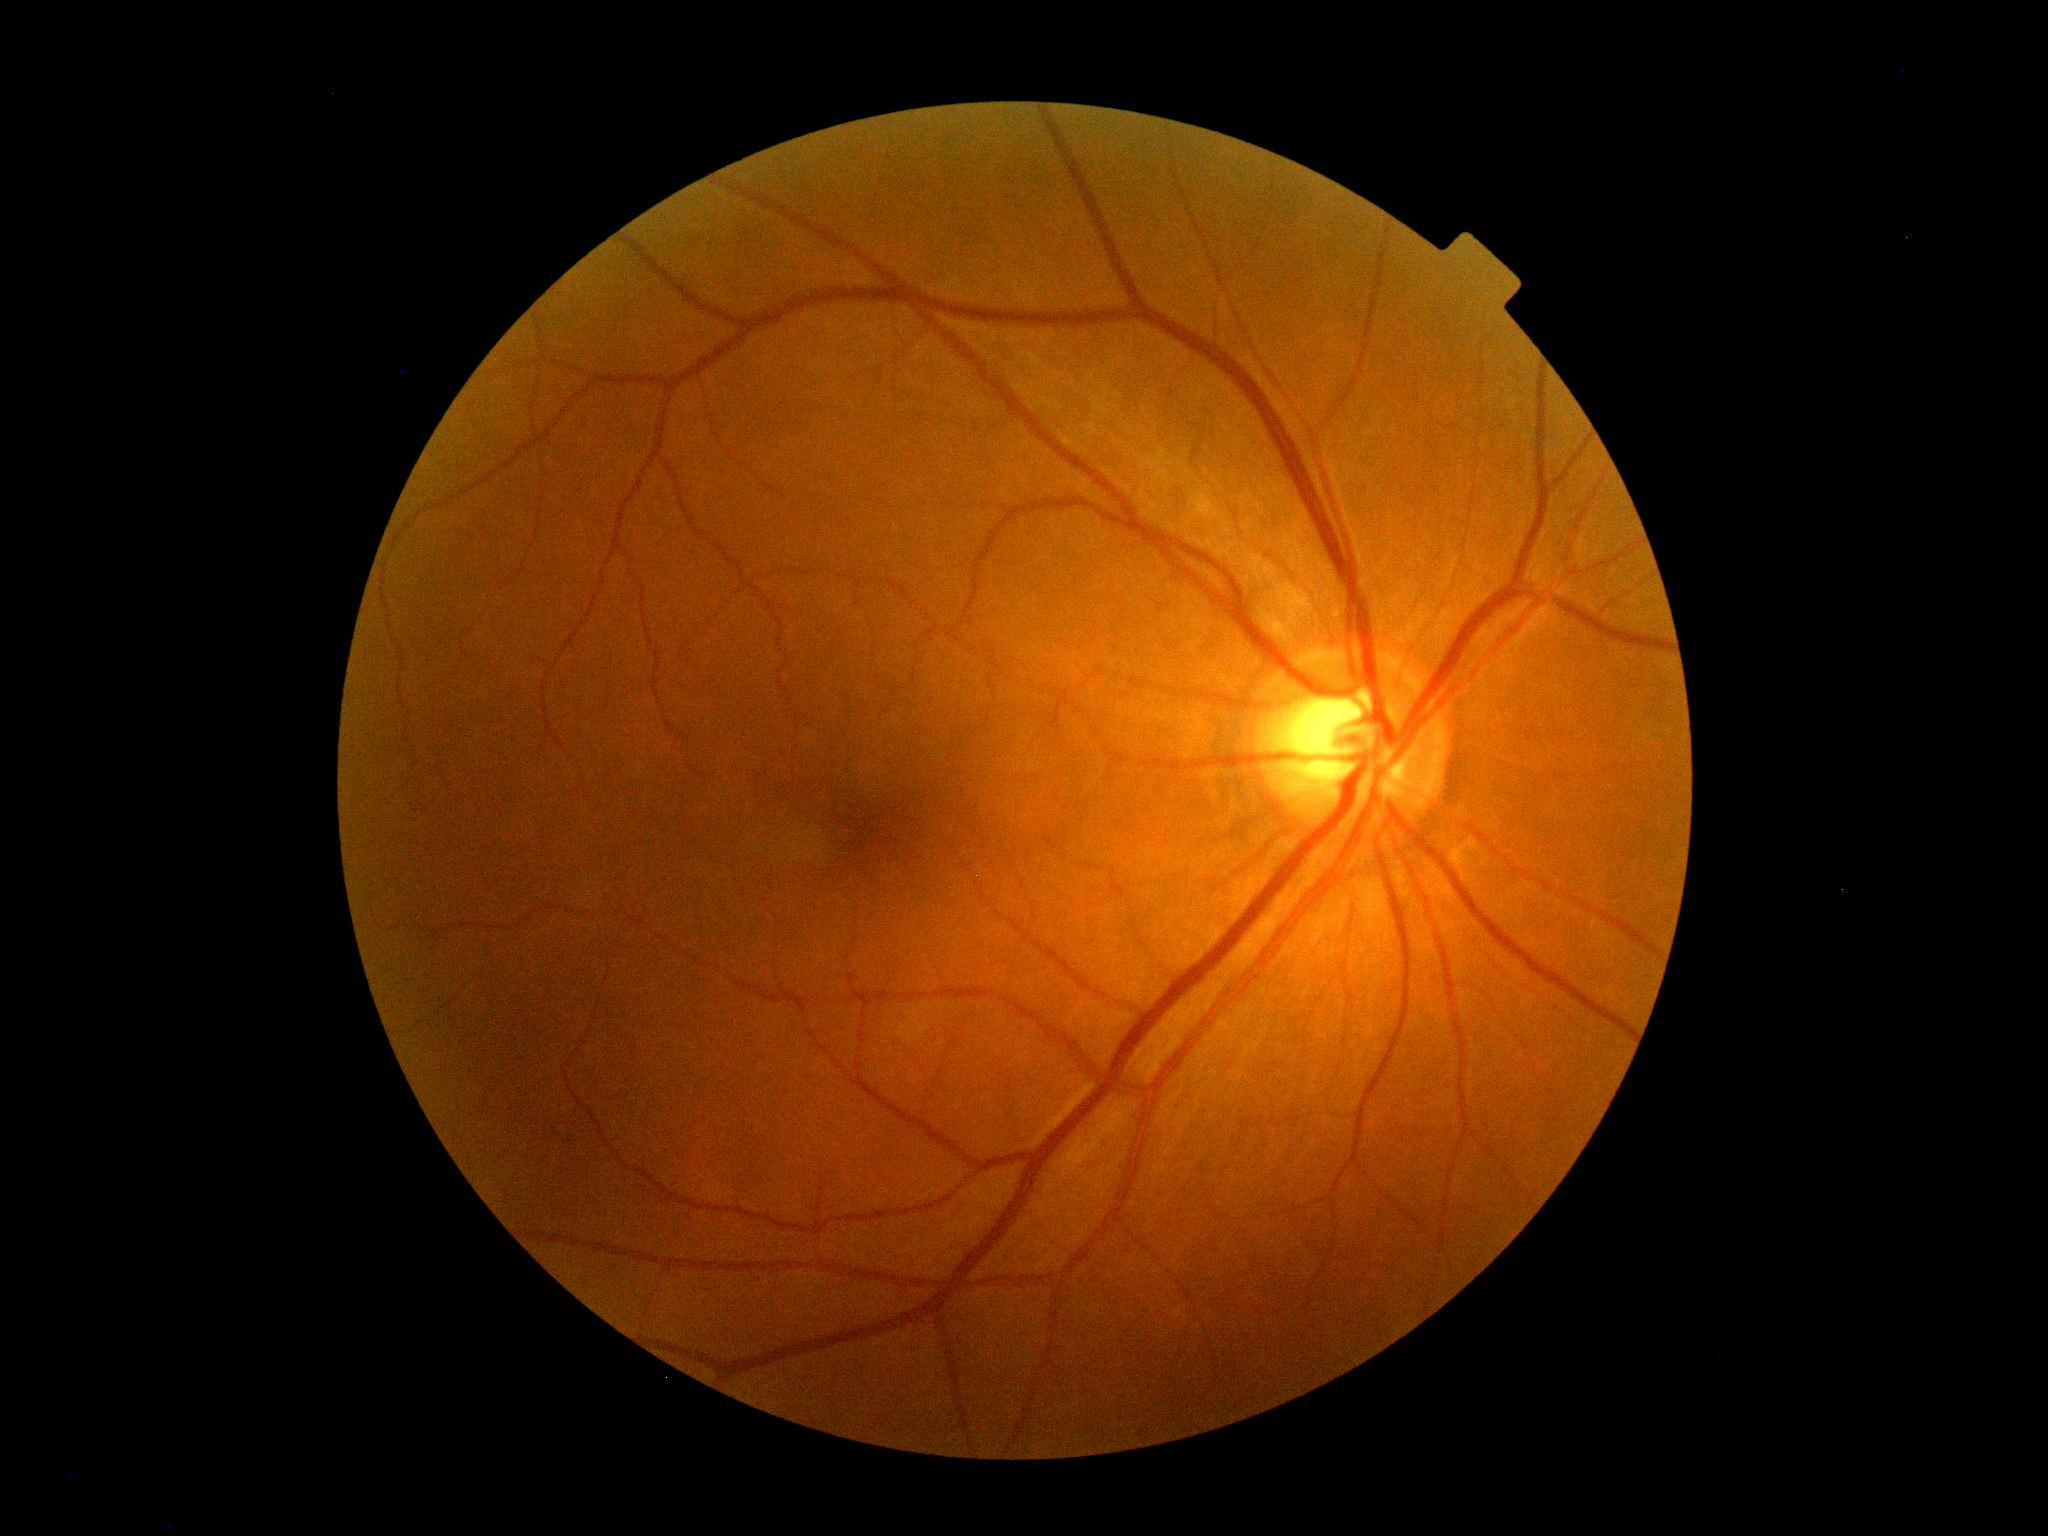
Diabetic retinopathy (DR) is grade 0 (no apparent retinopathy).